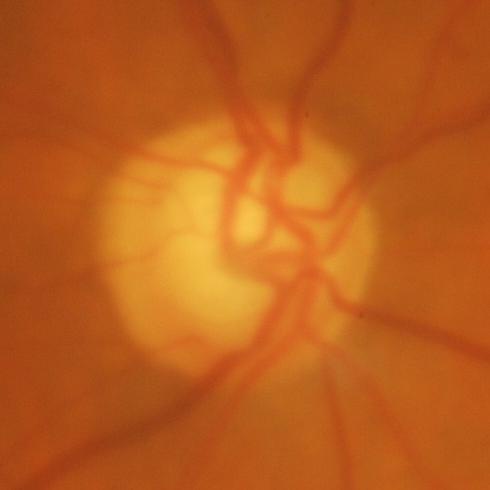
Demonstrates glaucomatous findings.